45° field of view. Nonmydriatic fundus photograph:
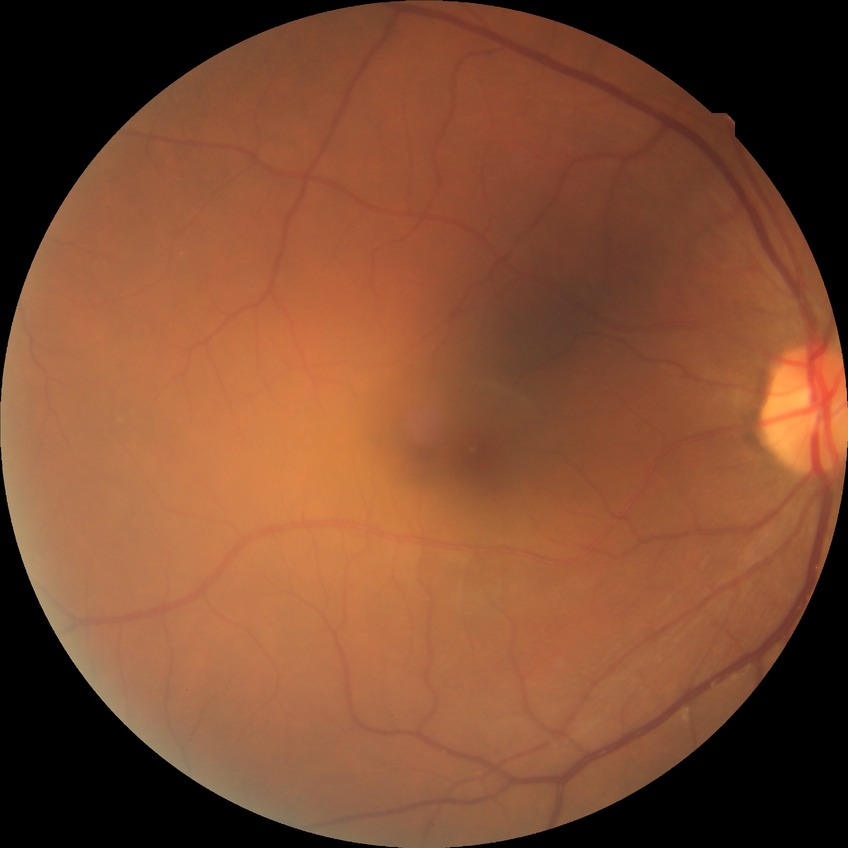

Diabetic retinopathy (DR) is no diabetic retinopathy (NDR).